Color fundus photograph; FOV: 45 degrees; acquired with a NIDEK AFC-230; 848 by 848 pixels: 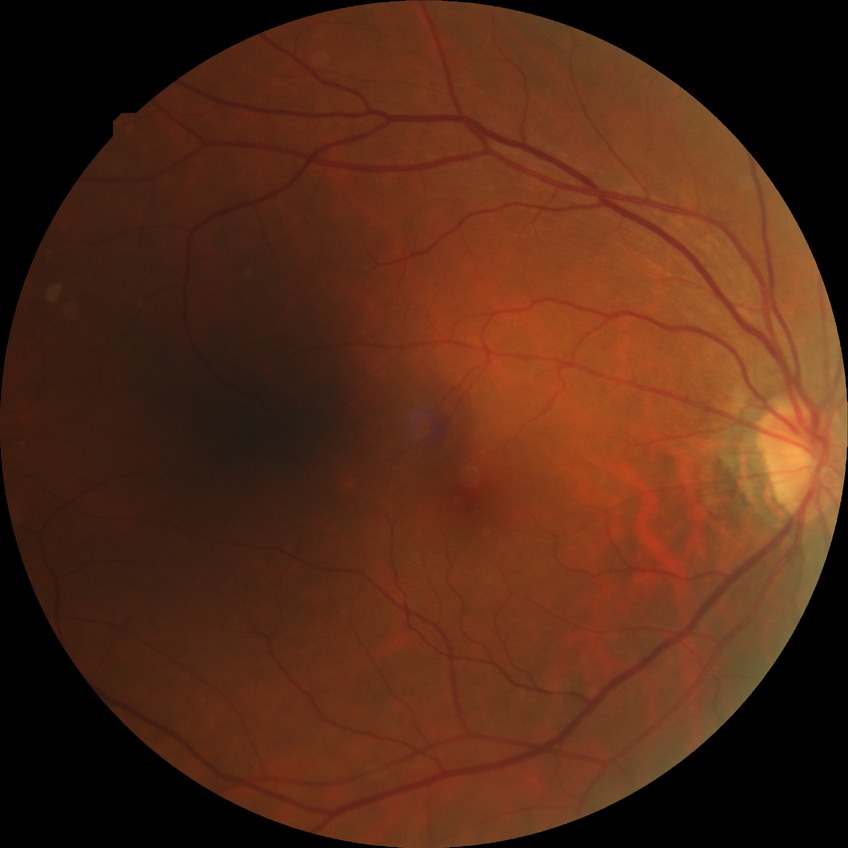
modified Davis classification = no diabetic retinopathy.